NIDEK AFC-230 fundus camera, DR severity per modified Davis staging, nonmydriatic, 848 x 848 pixels:
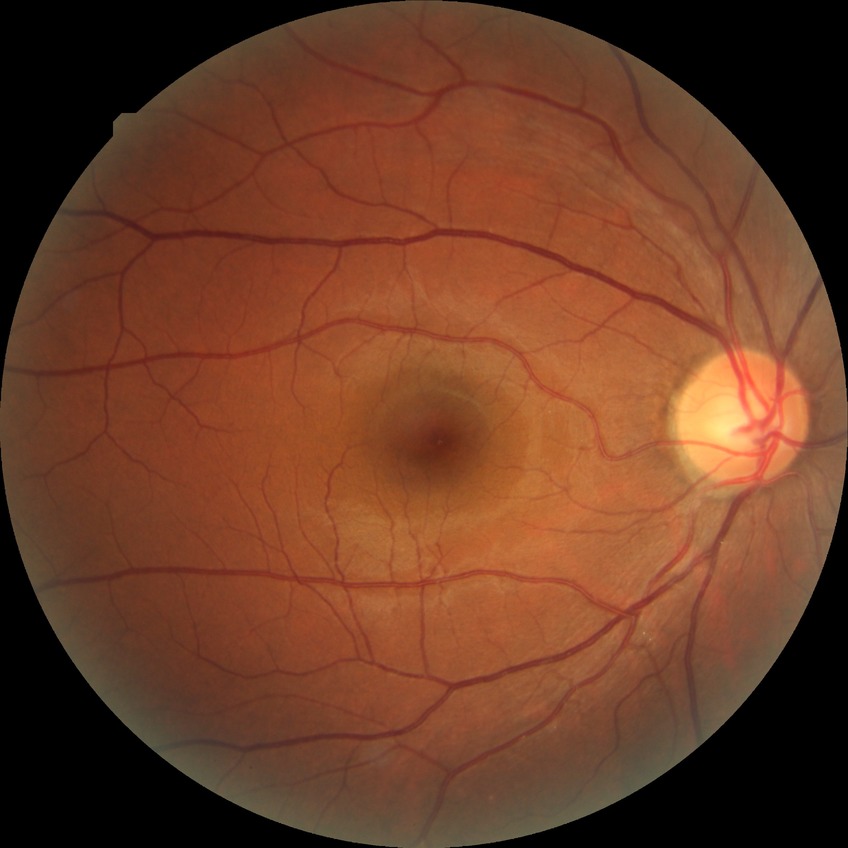
{"davis_grade": "no diabetic retinopathy (NDR)"}